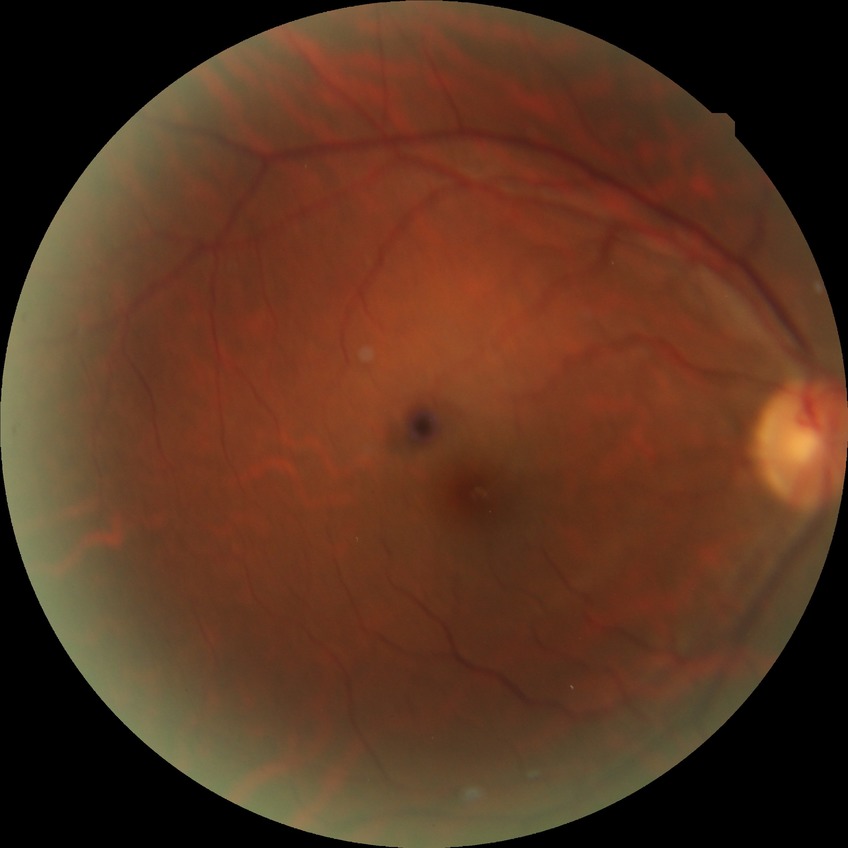 Diabetic retinopathy (DR): no diabetic retinopathy (NDR).